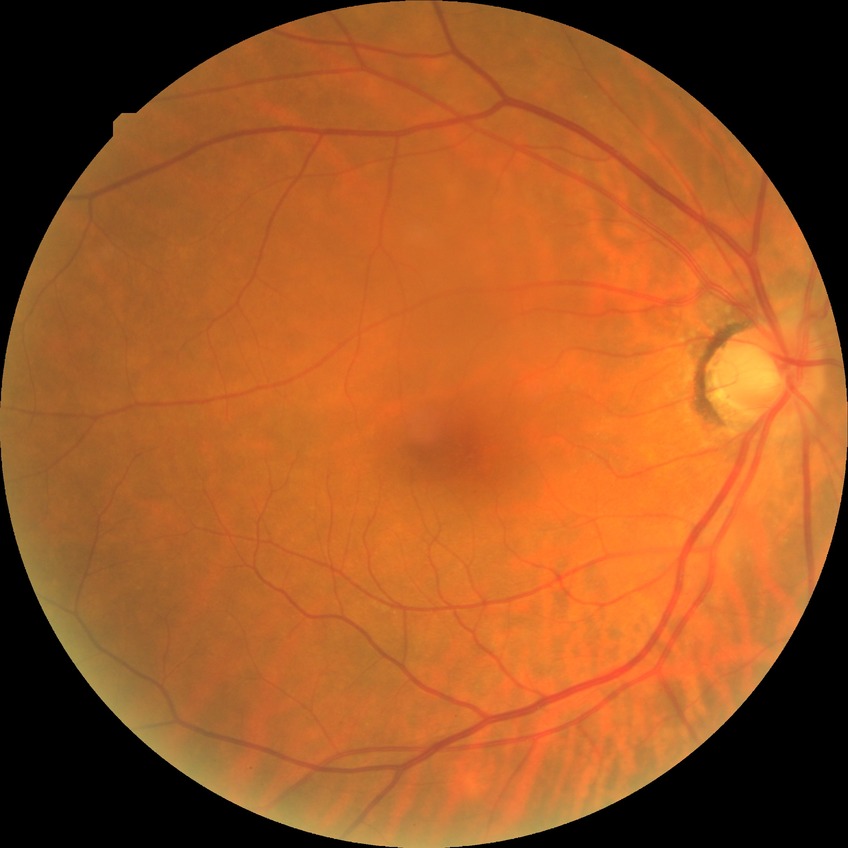

Diabetic retinopathy (DR): simple diabetic retinopathy (SDR).